848 by 848 pixels; modified Davis classification
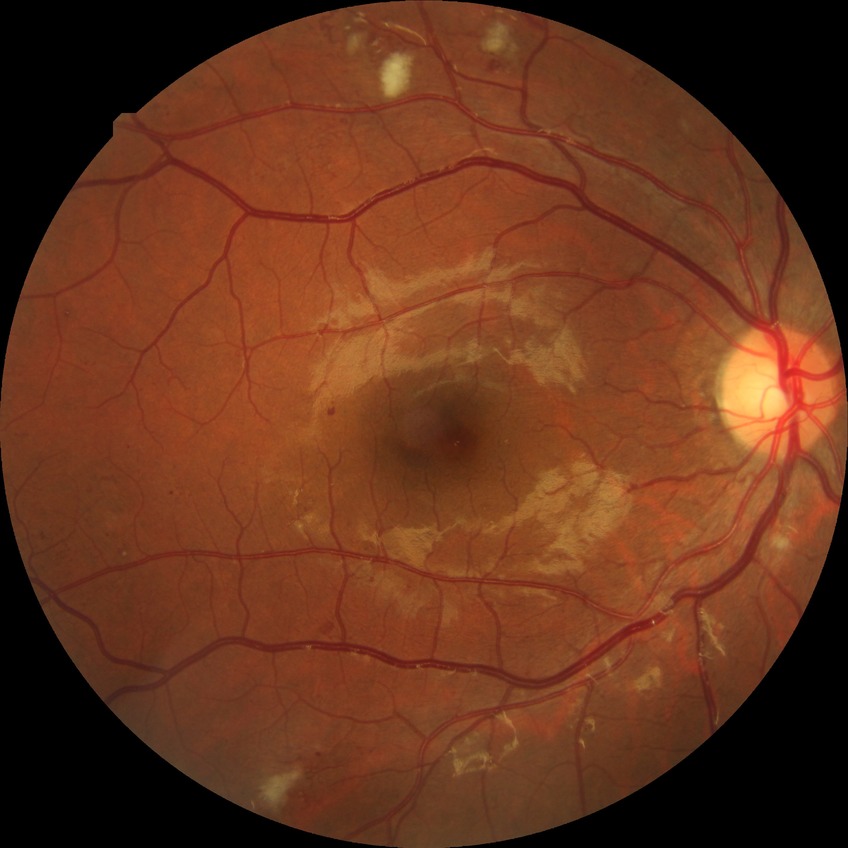

Diabetic retinopathy (DR): pre-proliferative diabetic retinopathy (PPDR). DR class: non-proliferative diabetic retinopathy.